45° field of view: 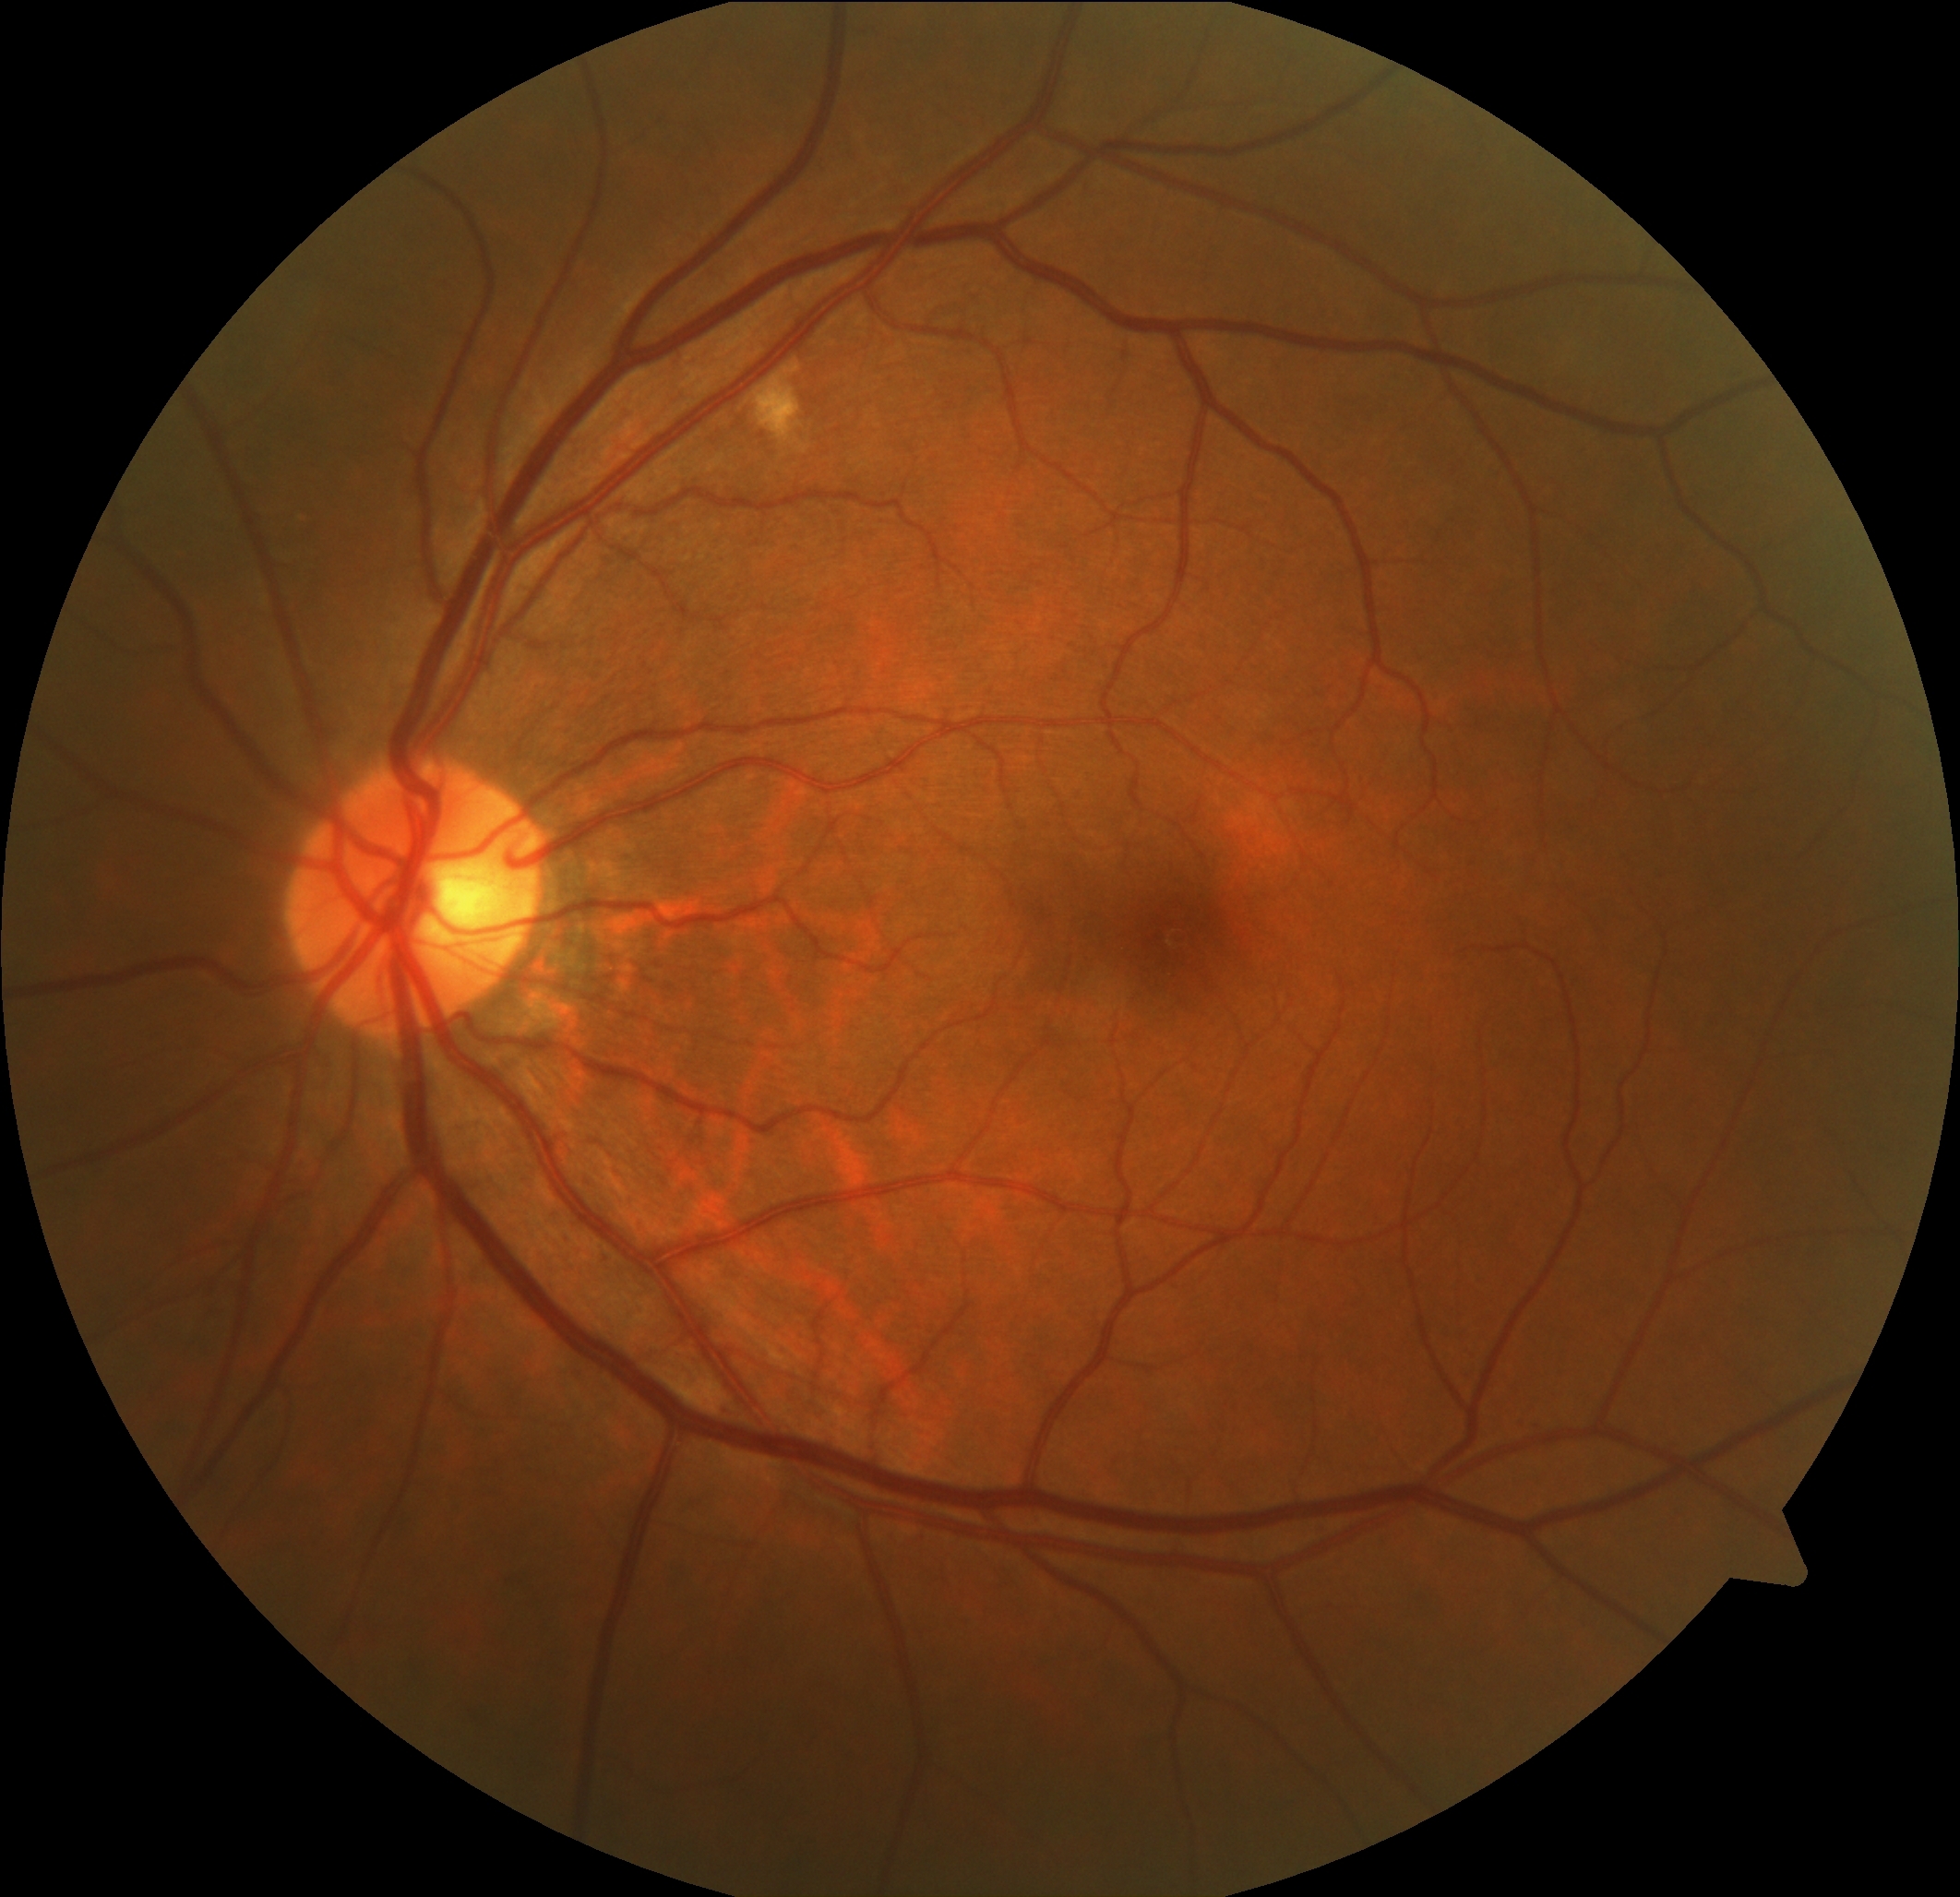
Disease class: non-proliferative diabetic retinopathy.
DR severity is grade 2.